2212 by 1659 pixels · 45° field of view · color fundus photograph
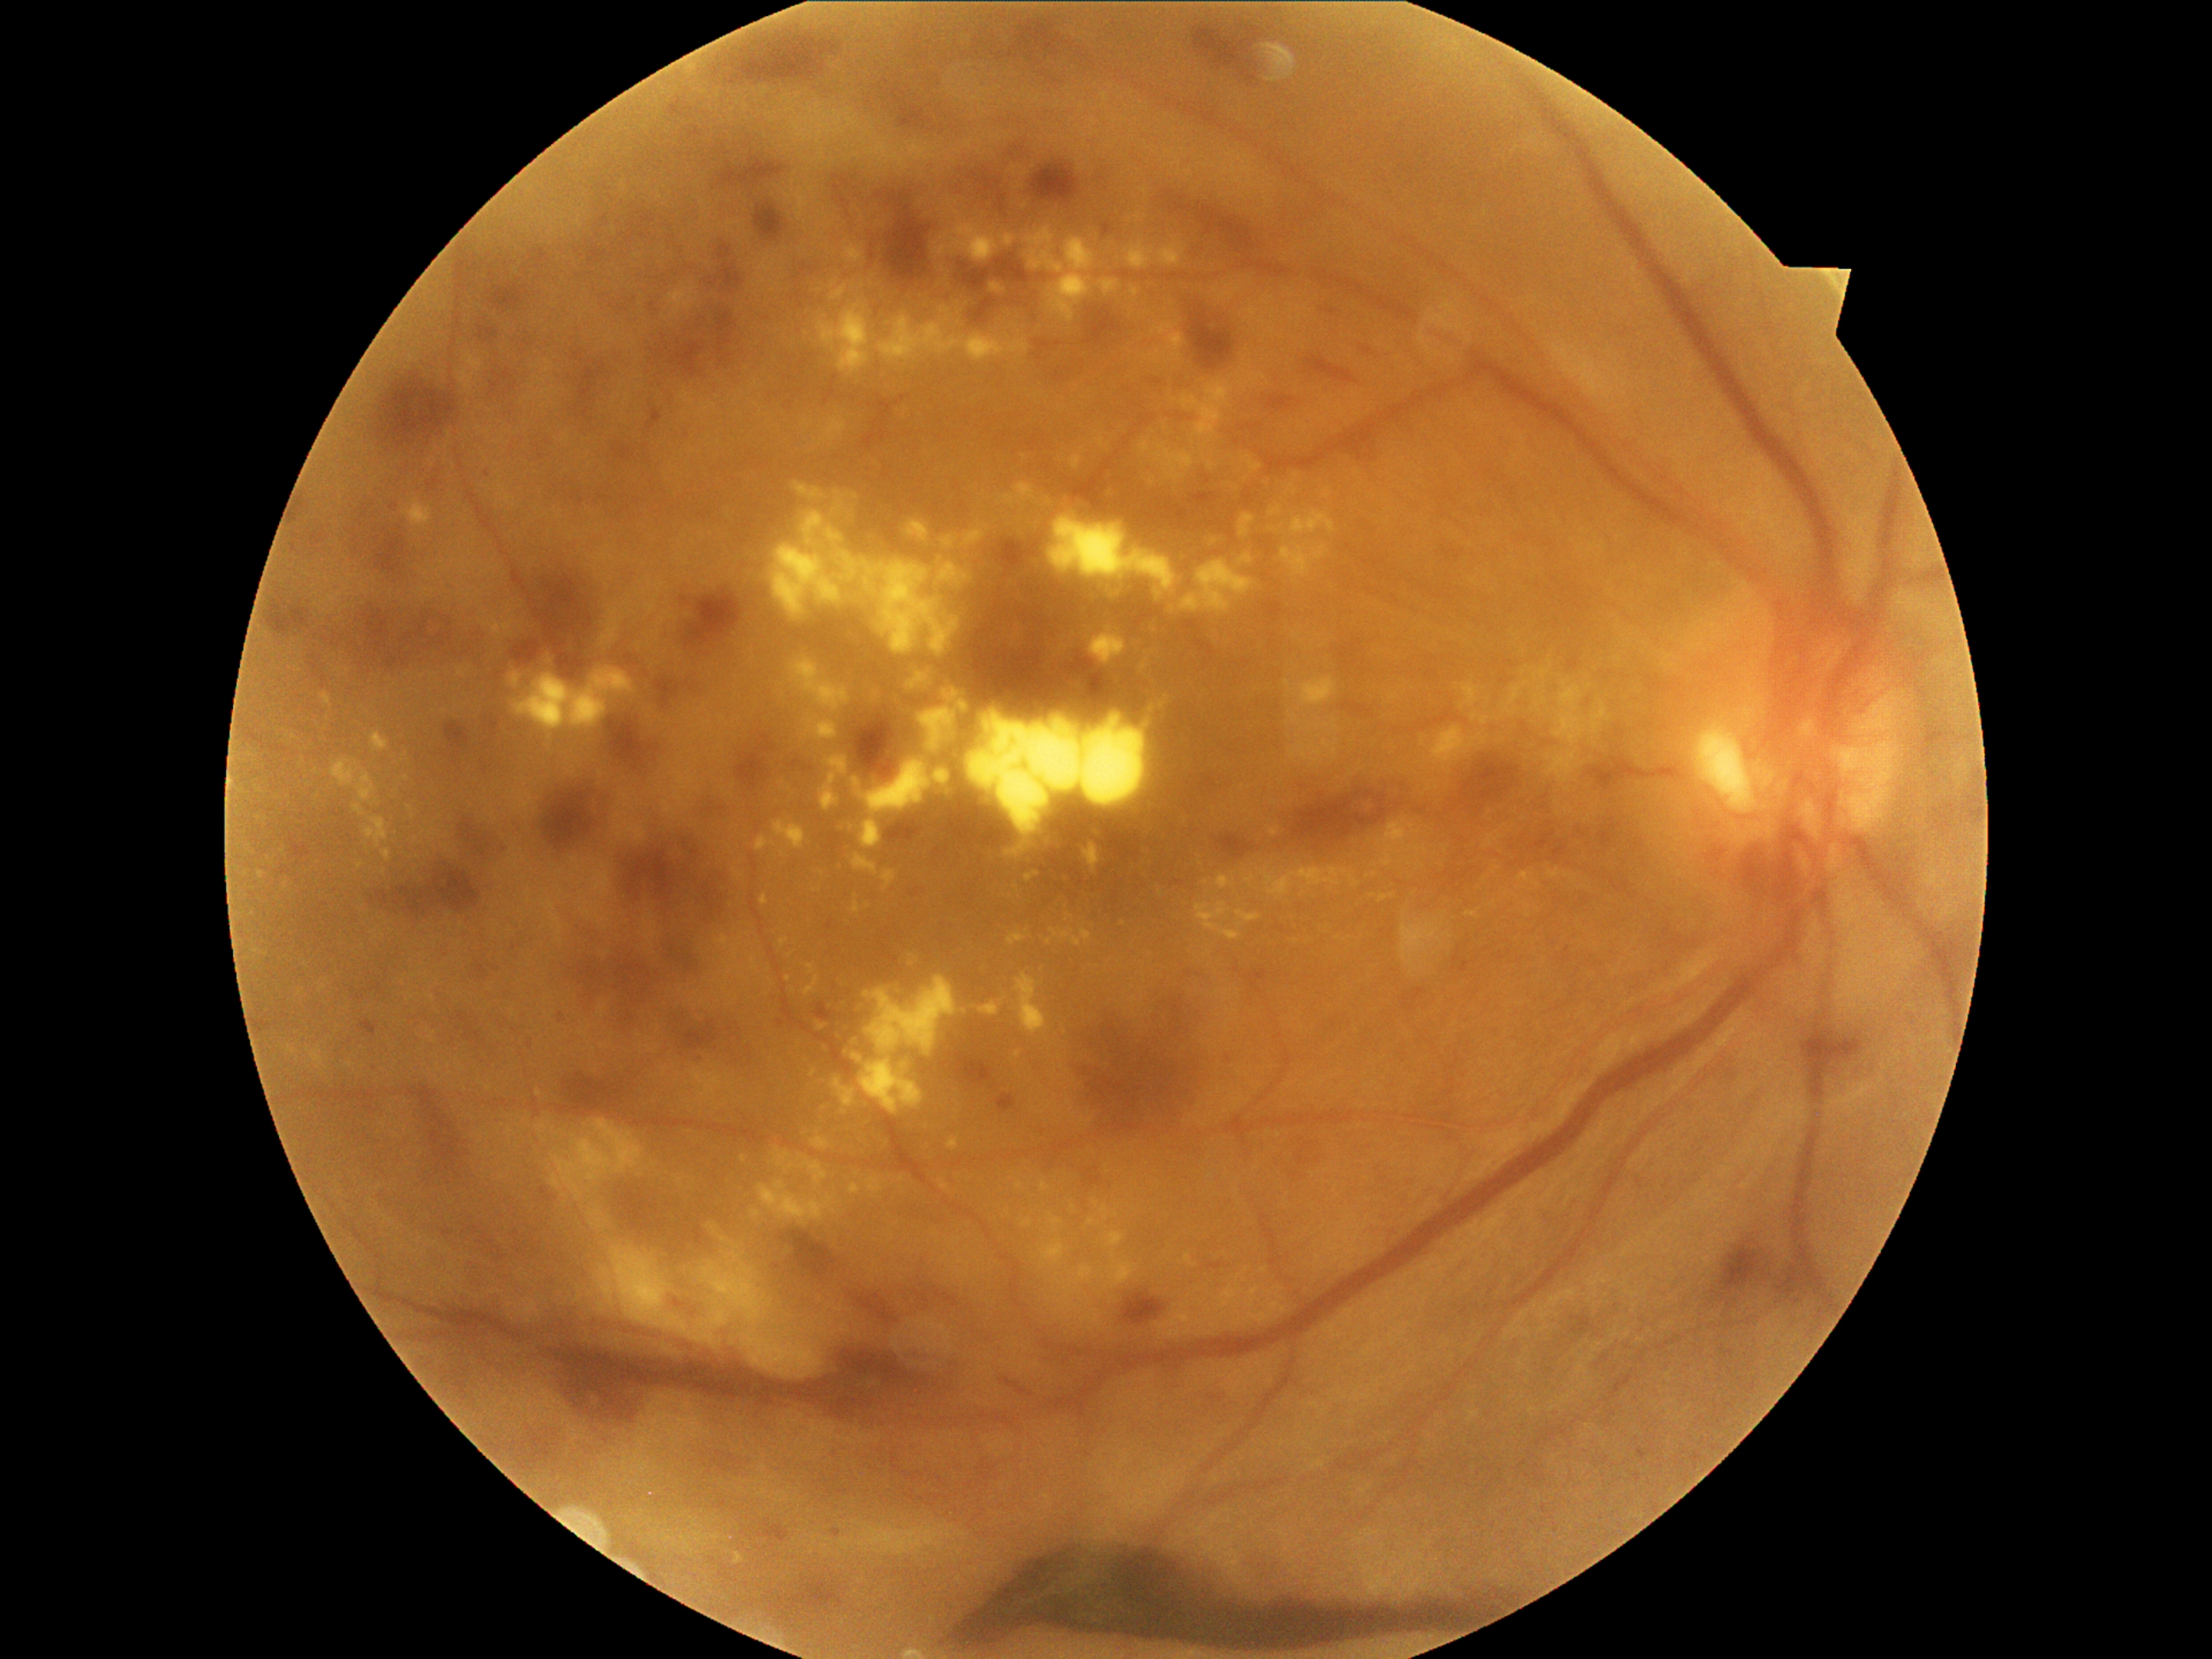
partial: true
dr_grade: 4
lesions:
  ex:
    - (1196,902,1240,941)
    - (960,702,969,711)
    - (1397,858,1412,866)
    - (1011,631,1023,646)
    - (1238,515,1255,537)
    - (805,713,839,740)
    - (1156,322,1175,335)
    - (1390,694,1399,701)
    - (1071,448,1085,470)
    - (1110,1264,1138,1288)
    - (1552,680,1612,747)
    - (1022,1218,1033,1226)
  ex_small_centers:
    - 1555/712
    - 1003/1001
    - 325/988
    - 1212/453
    - 444/847
    - 1548/758
    - 1163/704
    - 407/780